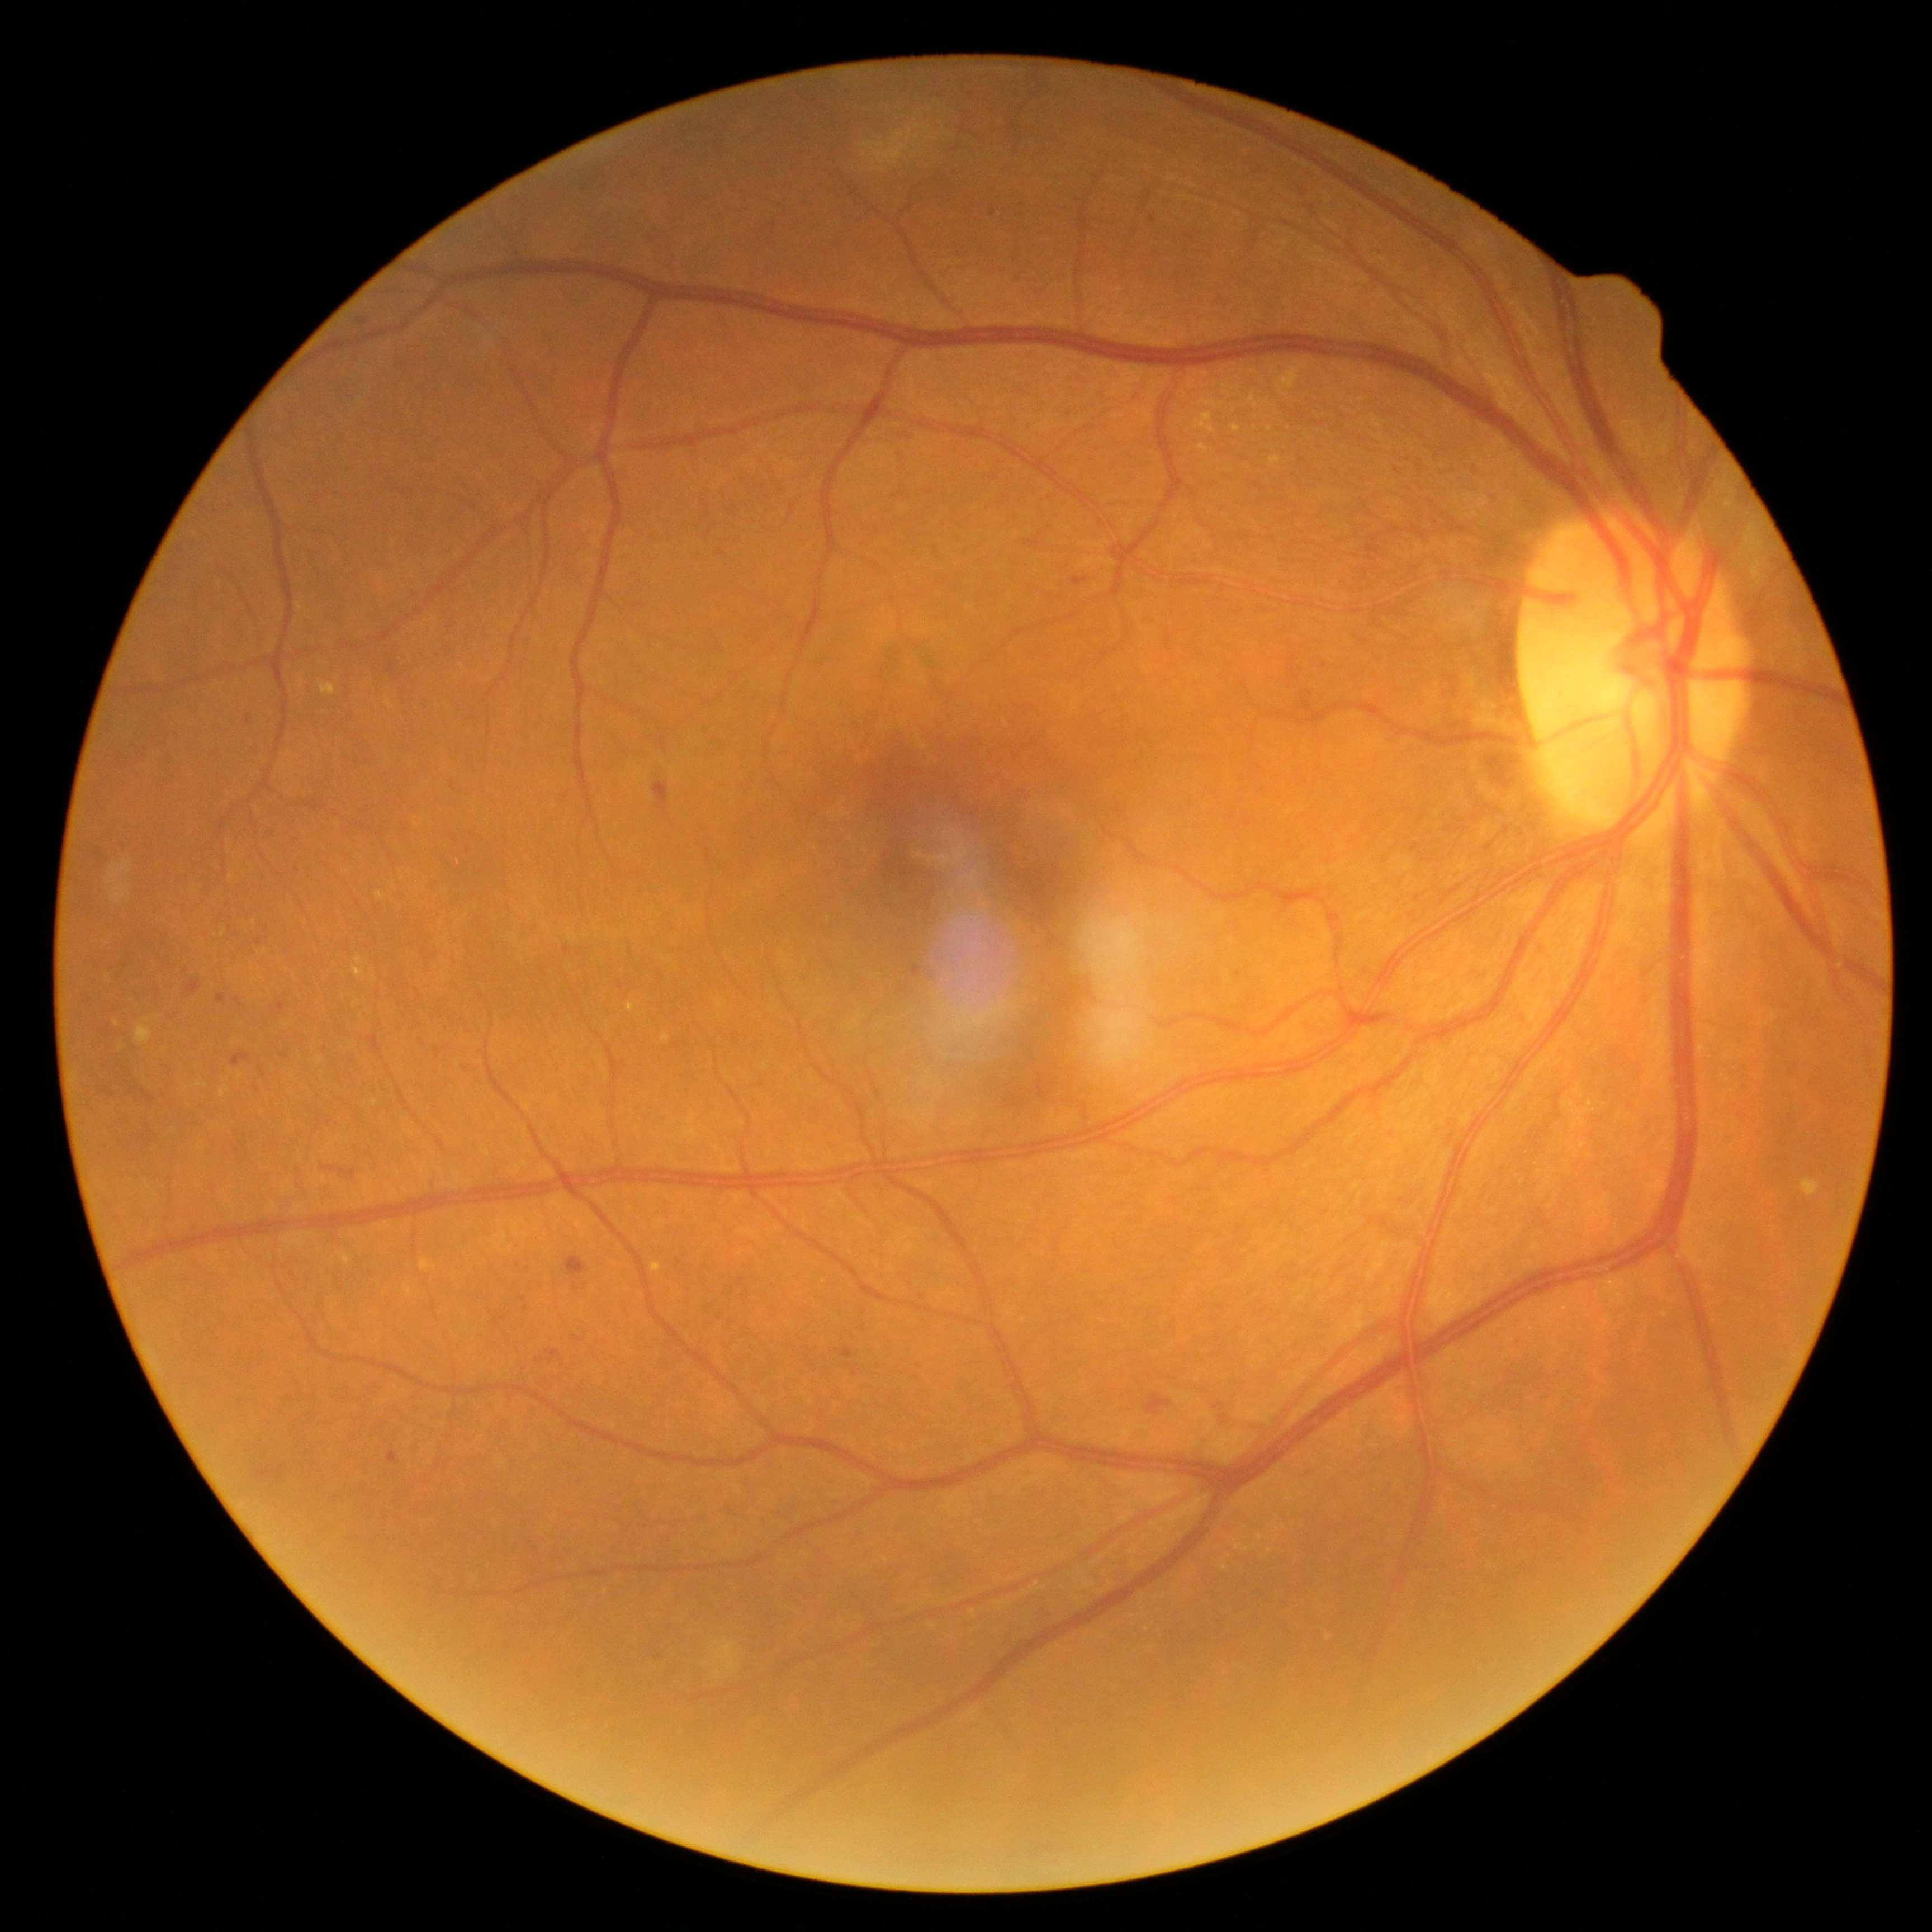
Diabetic retinopathy (DR): 2/4
Lesions identified (partial list):
• microaneurysms (MAs) (subset): [186, 979, 201, 996] | [248, 716, 253, 724] | [546, 1350, 561, 1359] | [94, 849, 103, 857] | [494, 1318, 499, 1327] | [659, 973, 665, 981] | [387, 1452, 399, 1465] | [101, 1088, 115, 1096]
• Smaller MAs around <pt>527,1309</pt> | <pt>437,1050</pt> | <pt>523,1300</pt> | <pt>468,851</pt> | <pt>773,225</pt> | <pt>567,952</pt> | <pt>630,952</pt> | <pt>620,985</pt>
• hard exudates (EXs) (subset): [650, 1263, 661, 1273] | [1270, 457, 1281, 465] | [1199, 444, 1208, 452] | [136, 1025, 153, 1046] | [377, 893, 386, 899] | [1194, 412, 1217, 434] | [339, 1254, 352, 1265] | [1246, 394, 1258, 411] | [627, 1002, 636, 1011]
• Smaller EXs around <pt>1270,1552</pt> | <pt>1236,388</pt> | <pt>1255,428</pt> | <pt>1329,1638</pt> | <pt>265,952</pt>